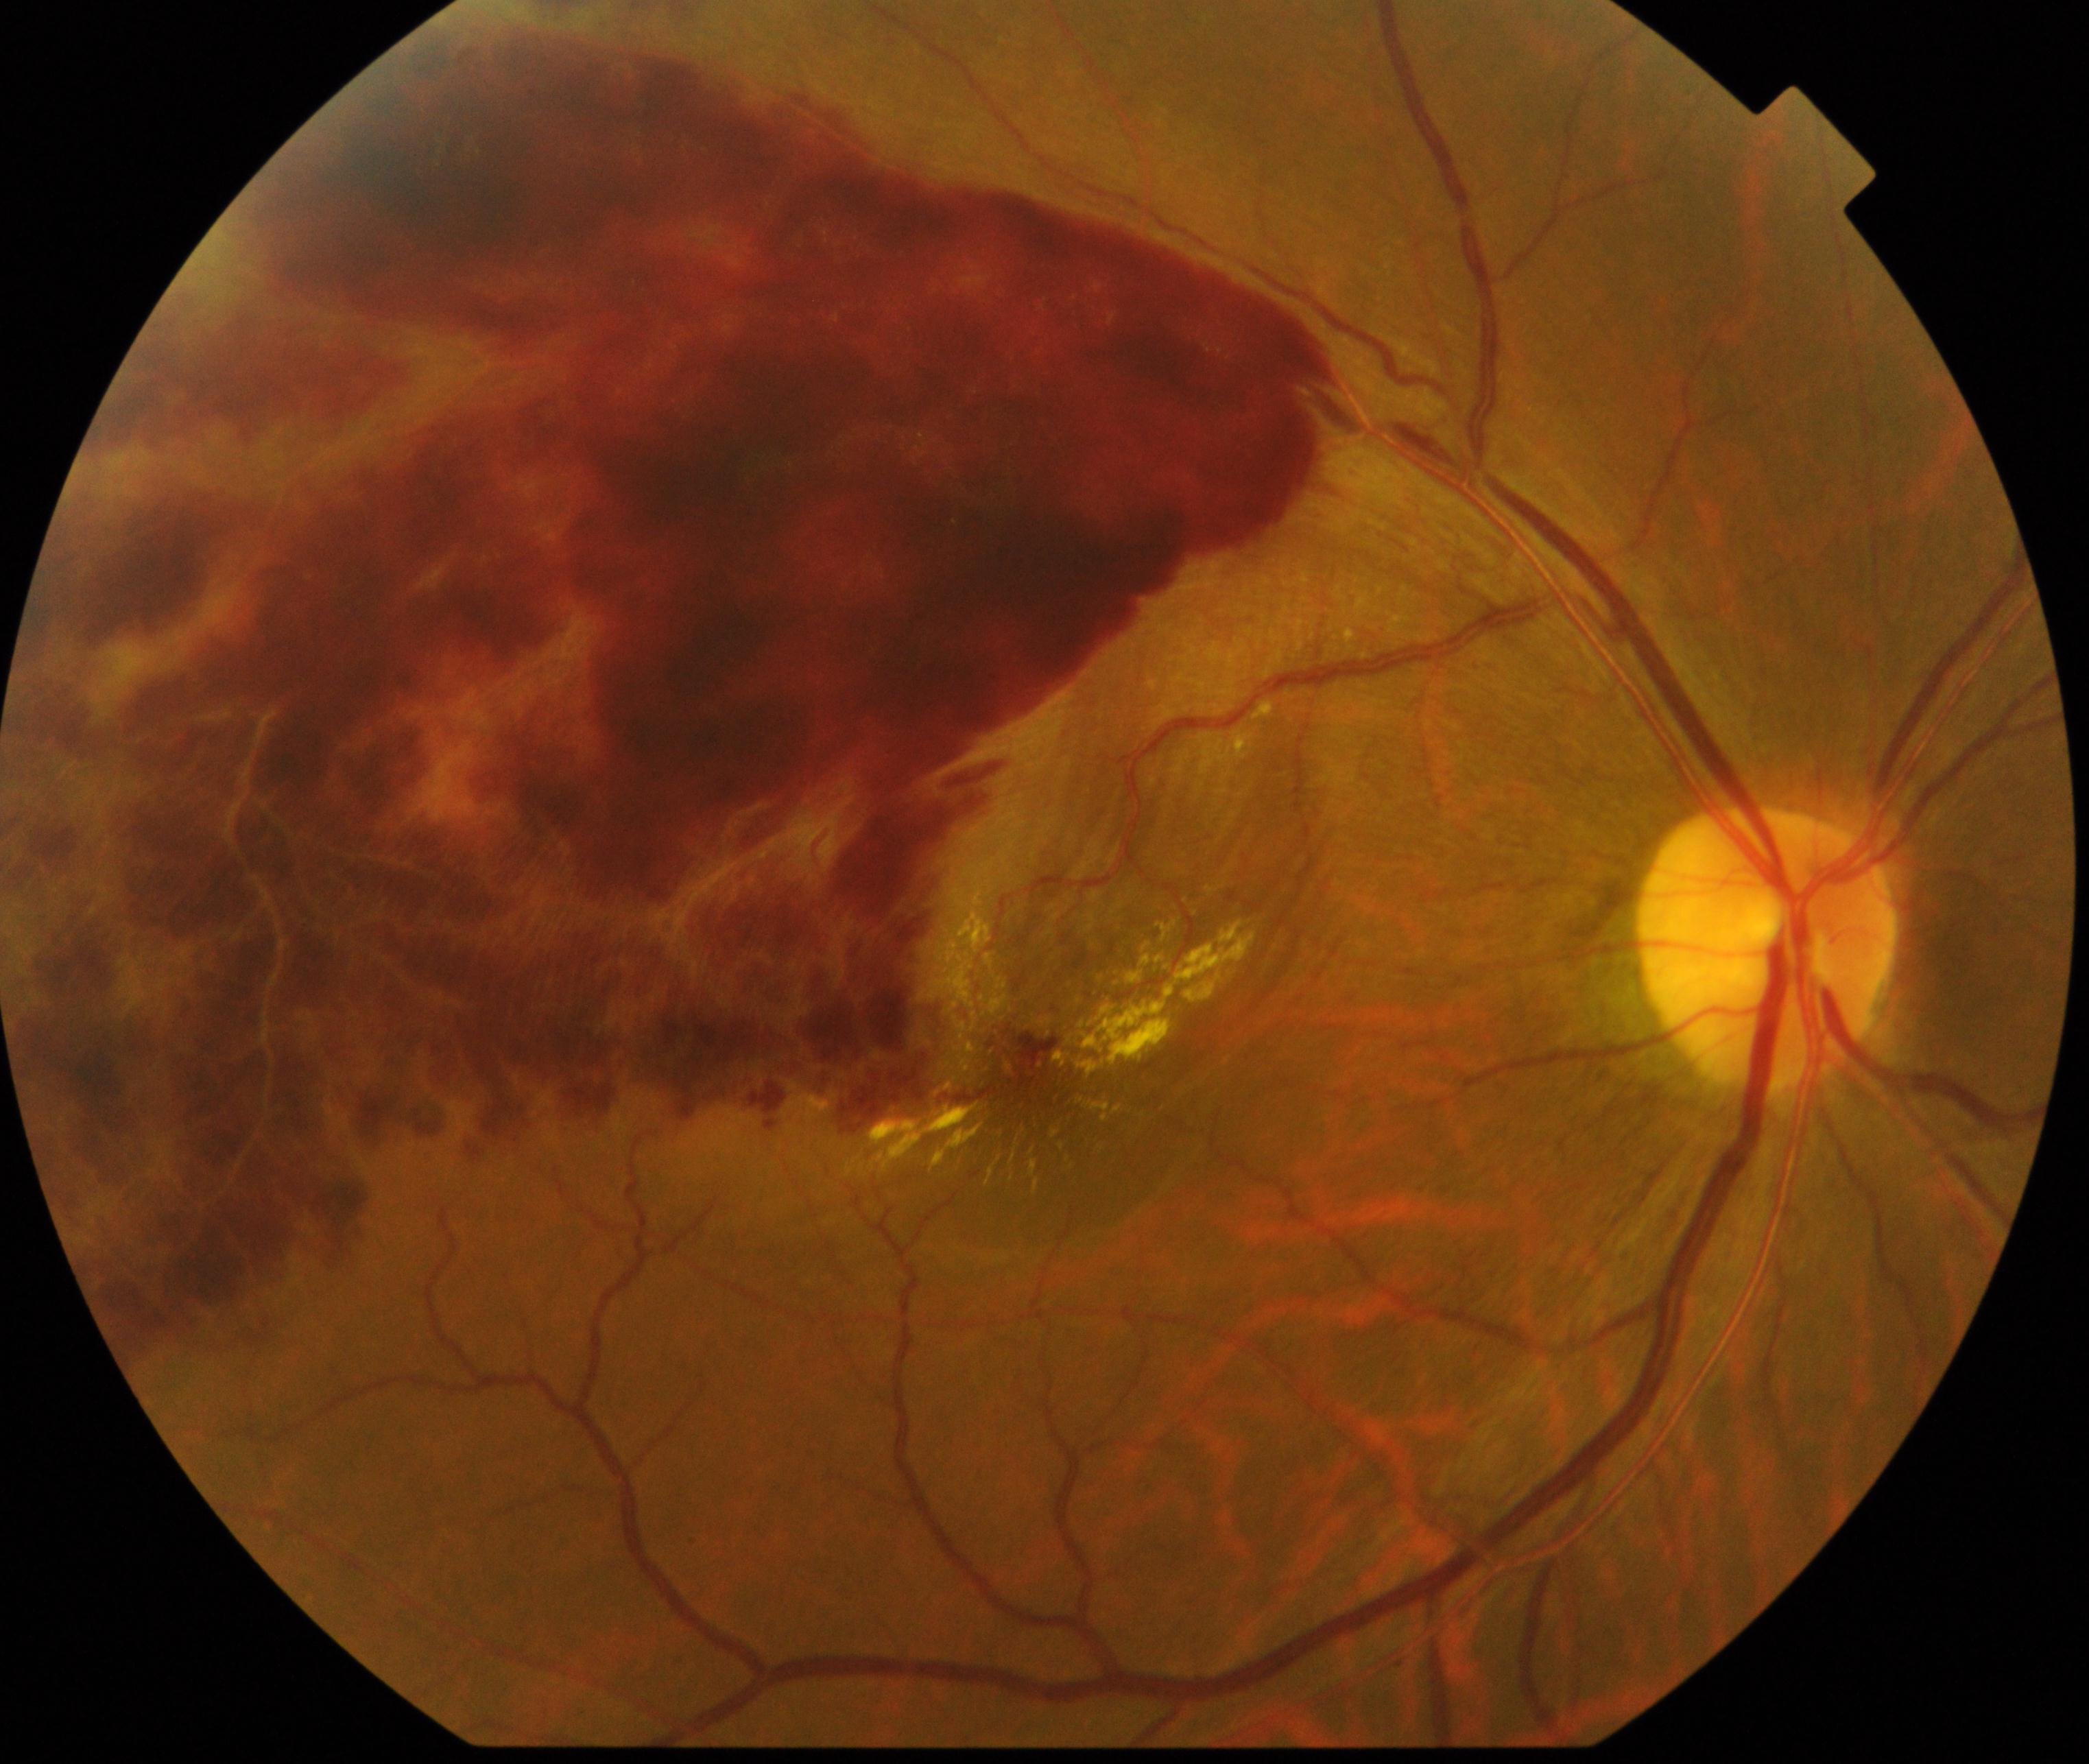

Classification: BRVO (branch retinal vein occlusion).